Phoenix ICON, 100° FOV; wide-field fundus image from infant ROP screening; image size 1240x1240 — 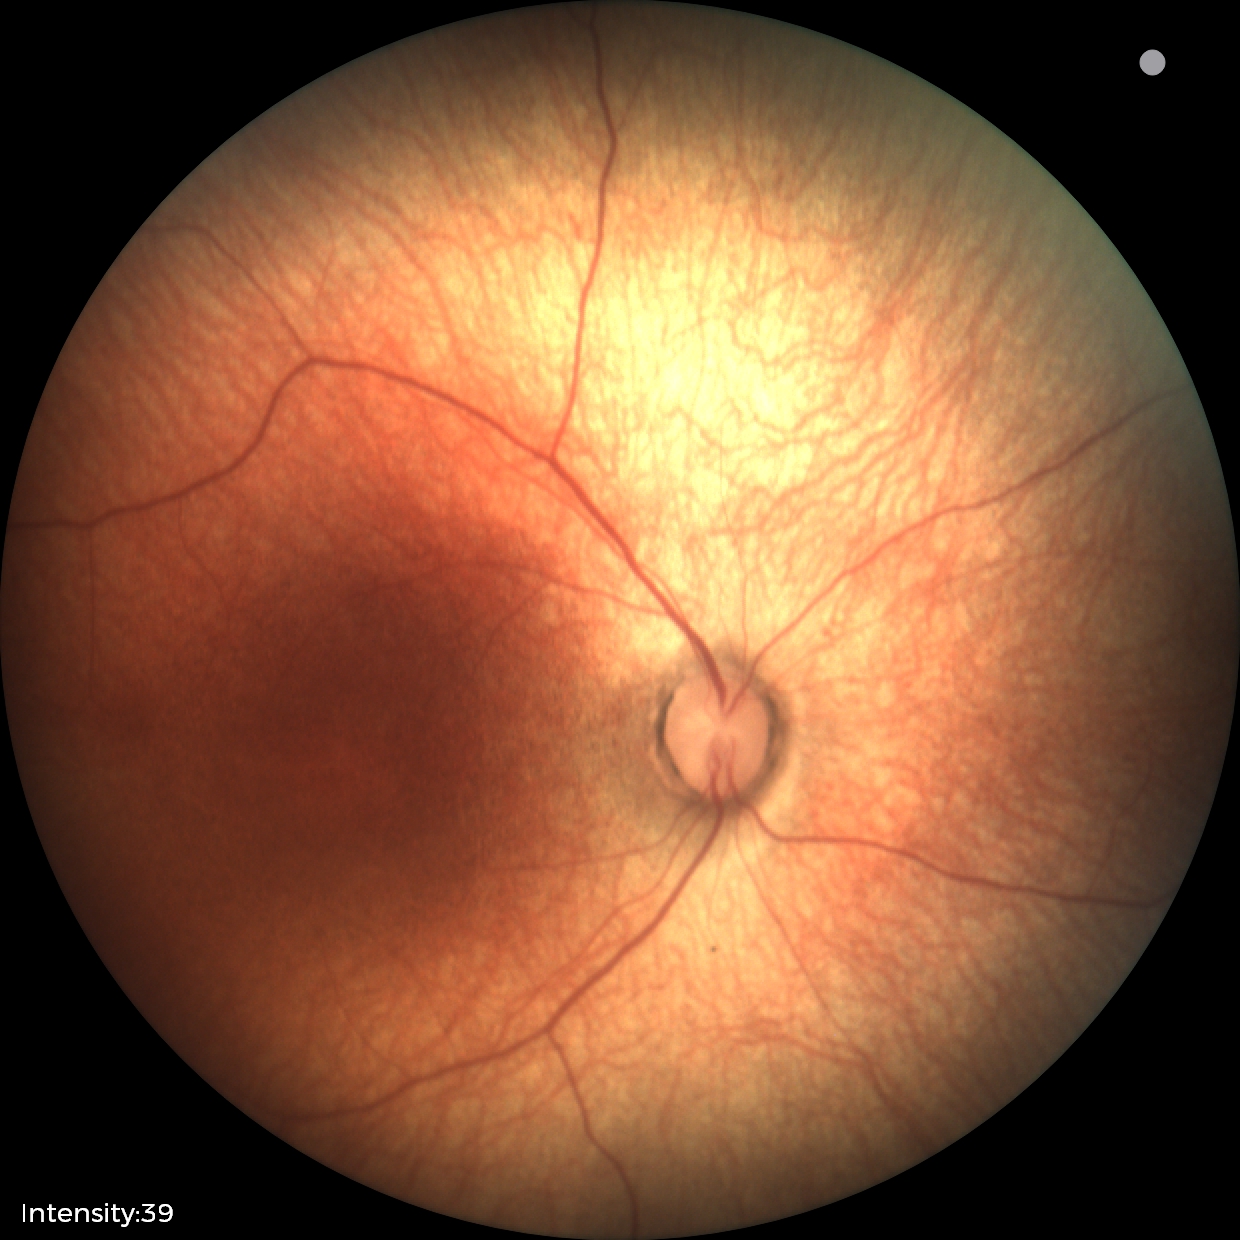
Screening: physiological retinal finding.